Retinal fundus photograph: 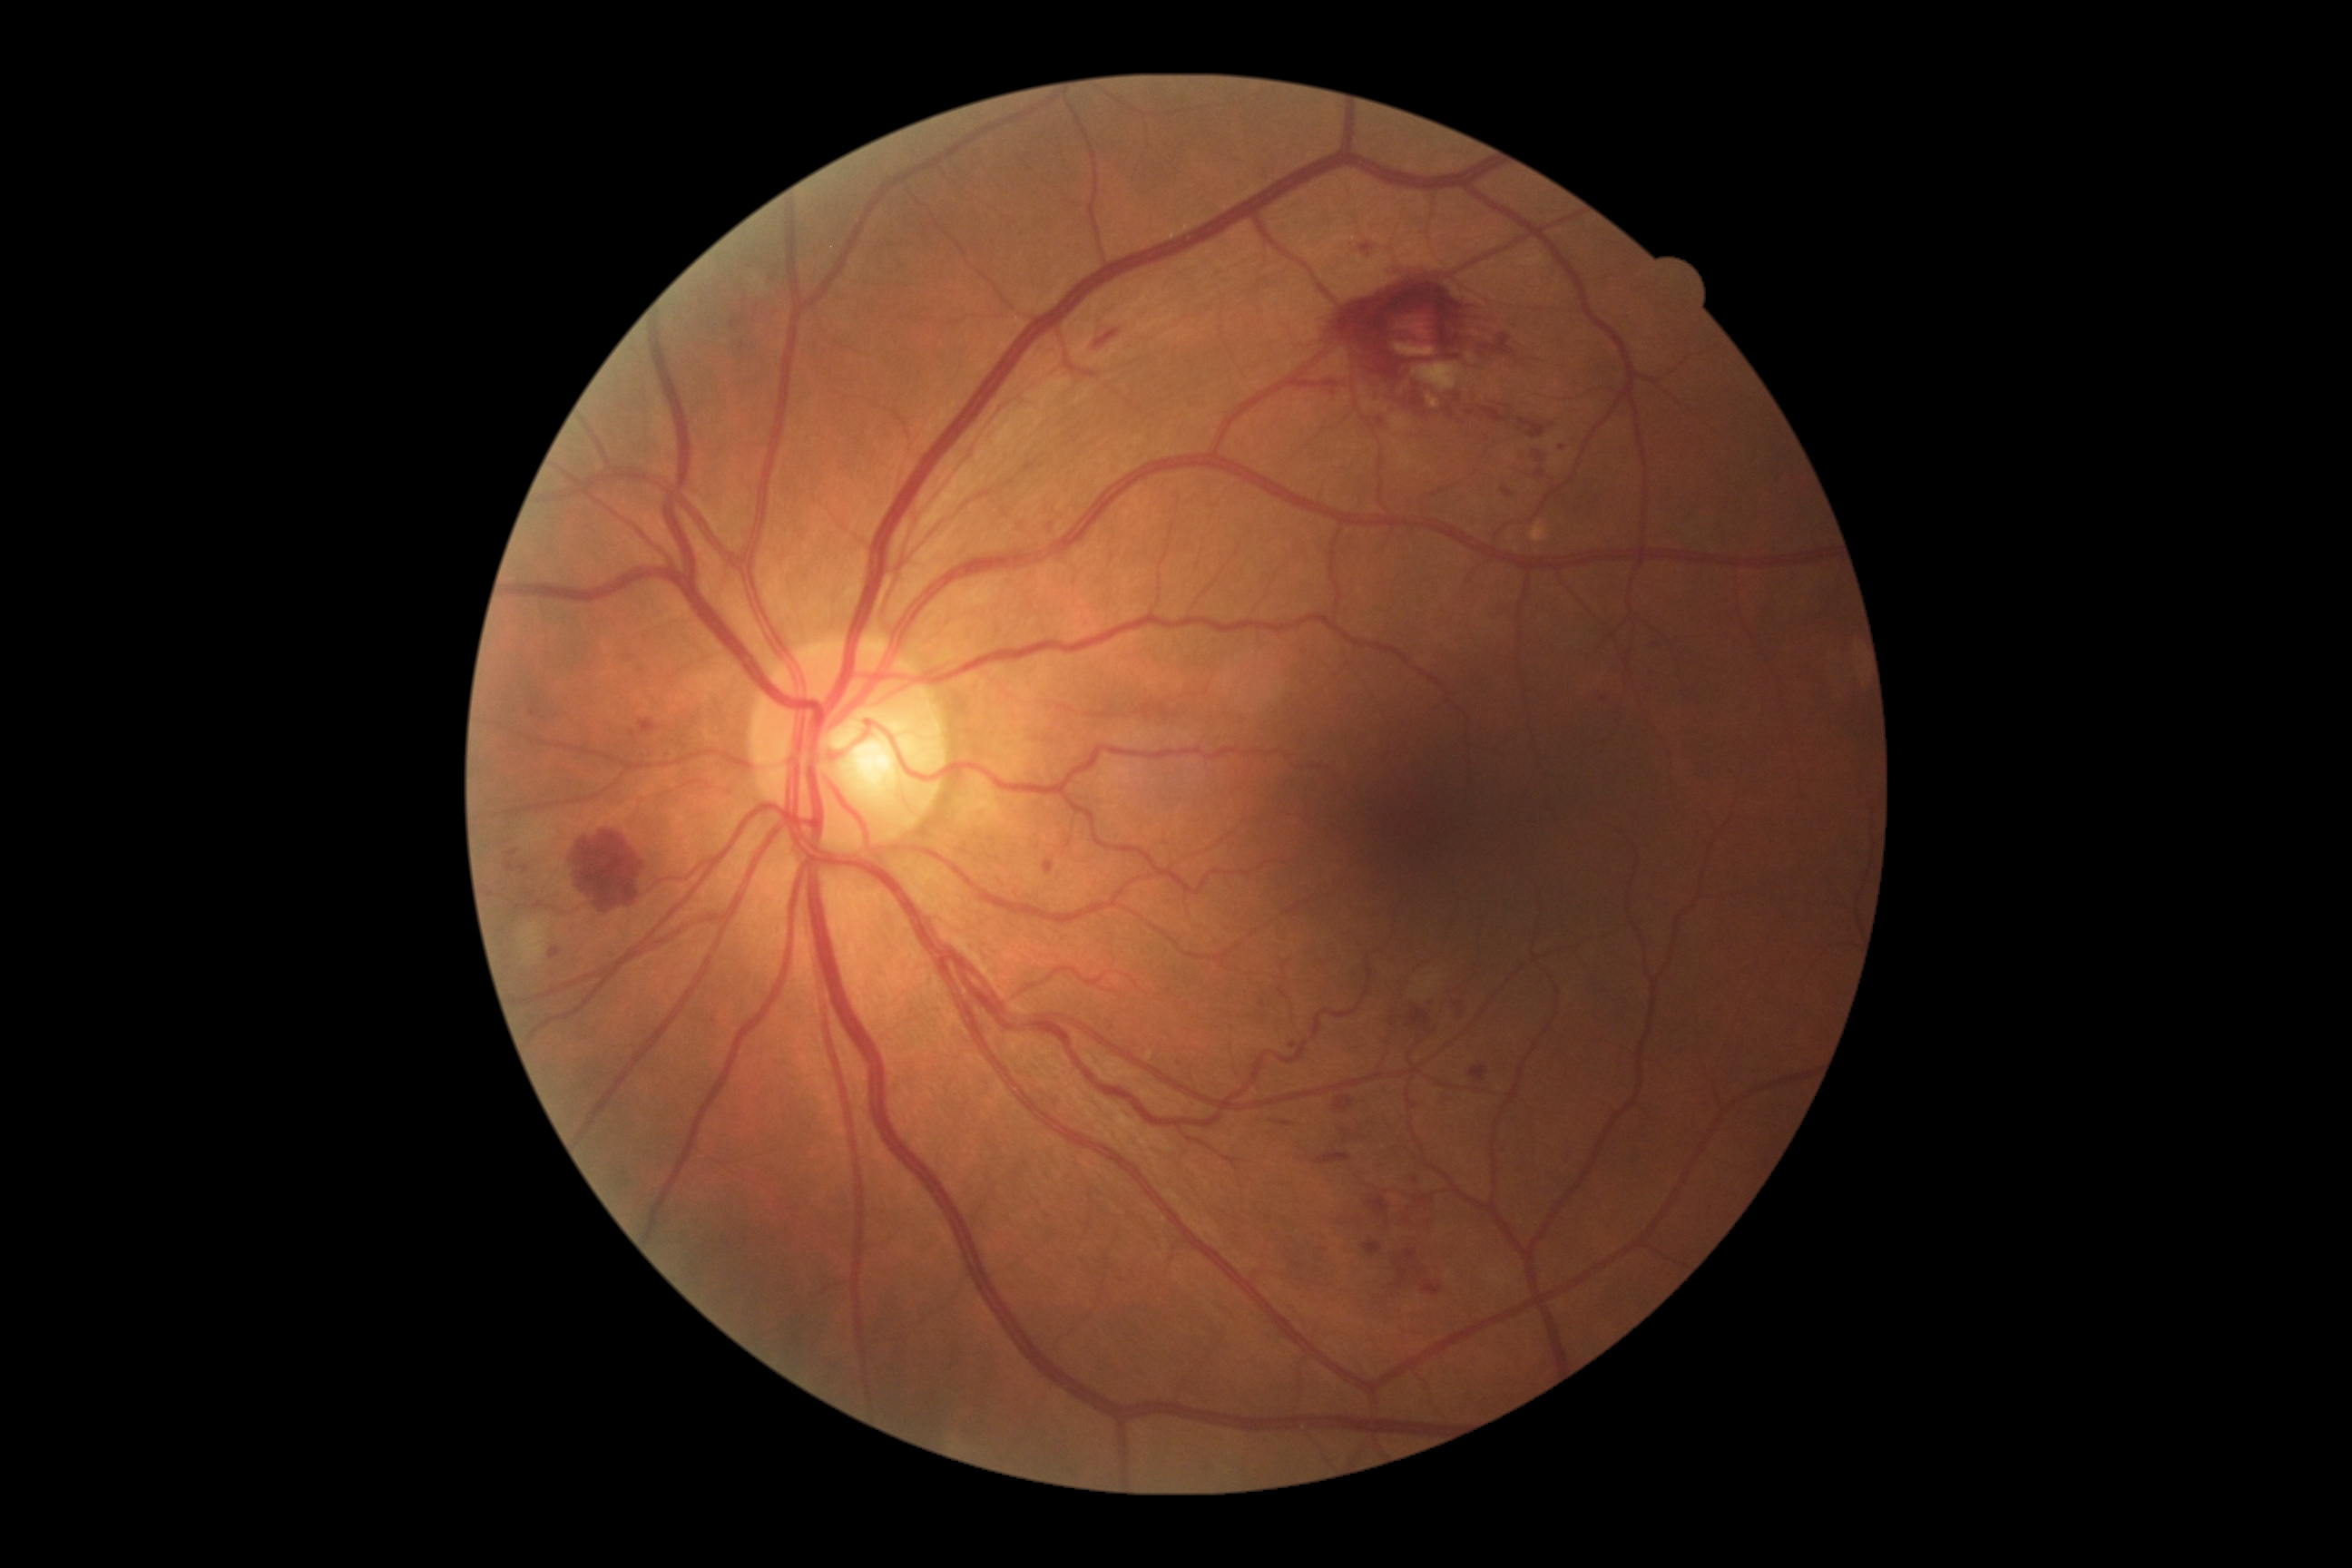 Disease class: non-proliferative diabetic retinopathy.
Diabetic retinopathy (DR) is moderate non-proliferative diabetic retinopathy (grade 2) — more than just microaneurysms but less than severe NPDR.